Camera: Natus RetCam Envision (130° FOV) · 1440x1080 · wide-field fundus image from infant ROP screening — 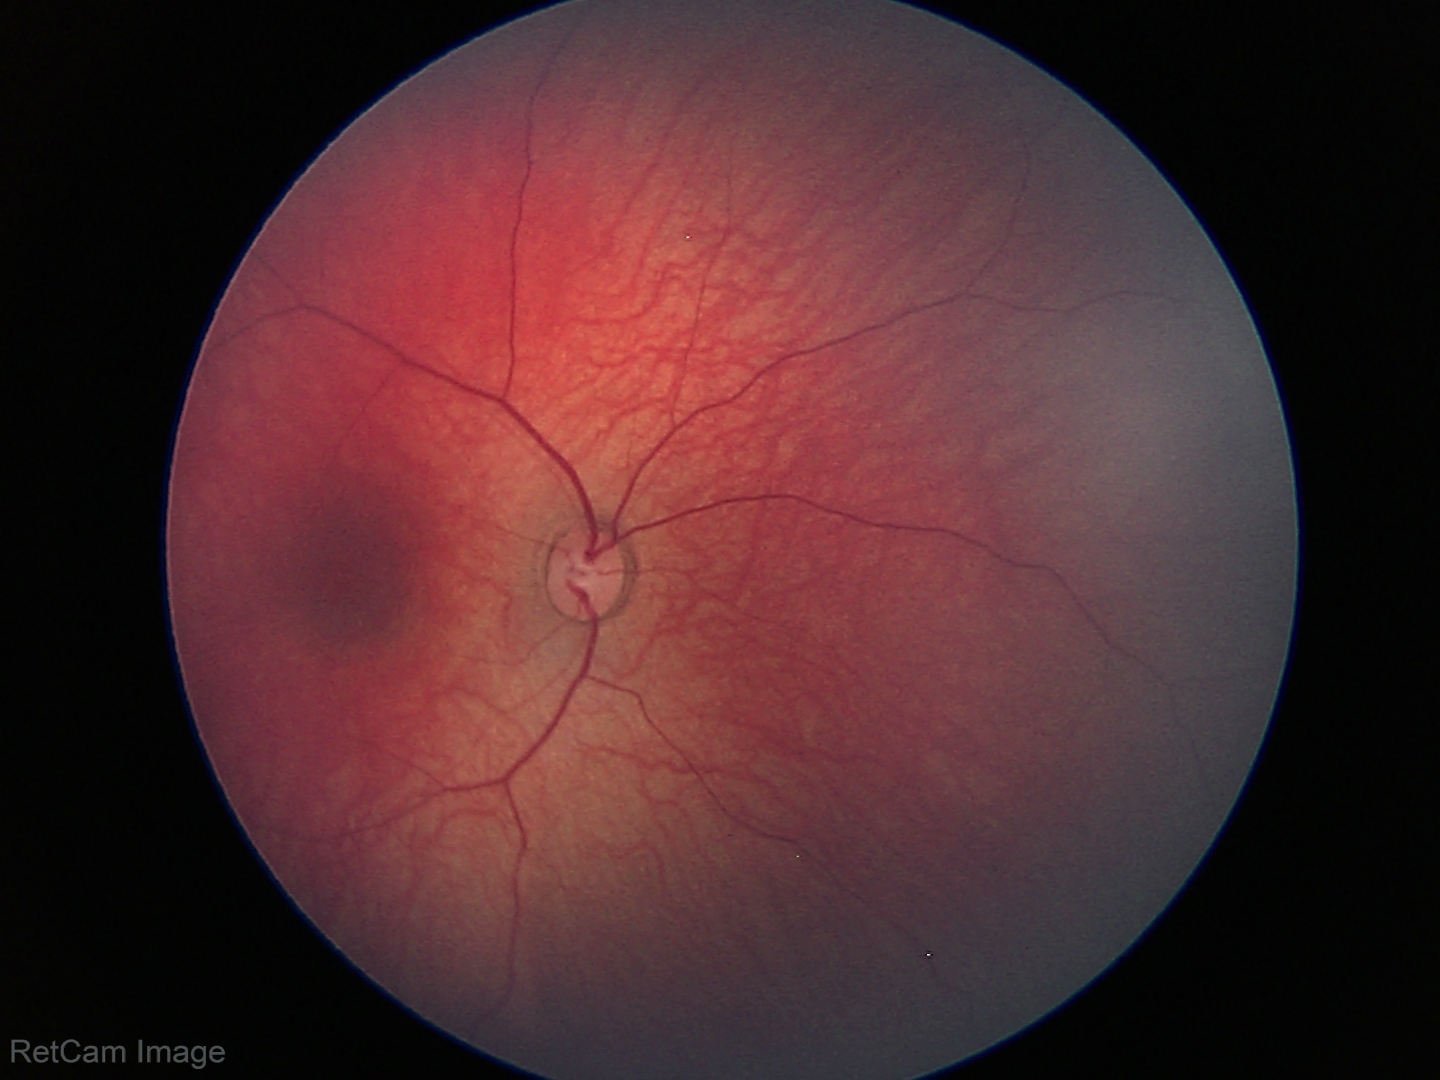

Diagnosis = no pathology identified